CFP · FOV: 45 degrees
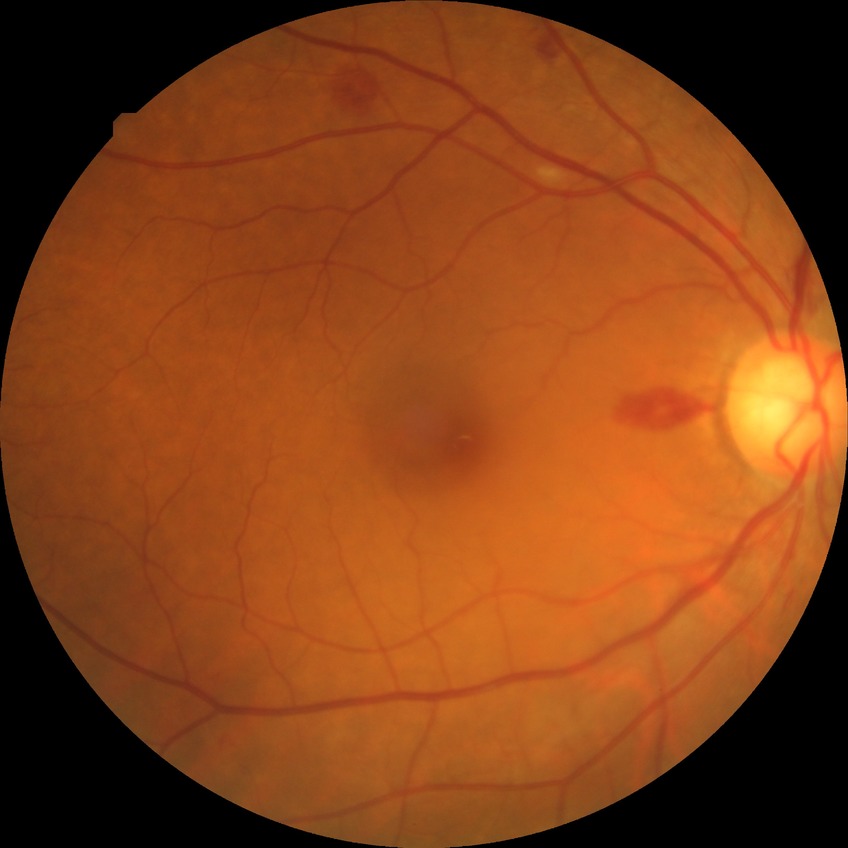

diabetic retinopathy (DR): SDR (simple diabetic retinopathy).